Fundus photo.
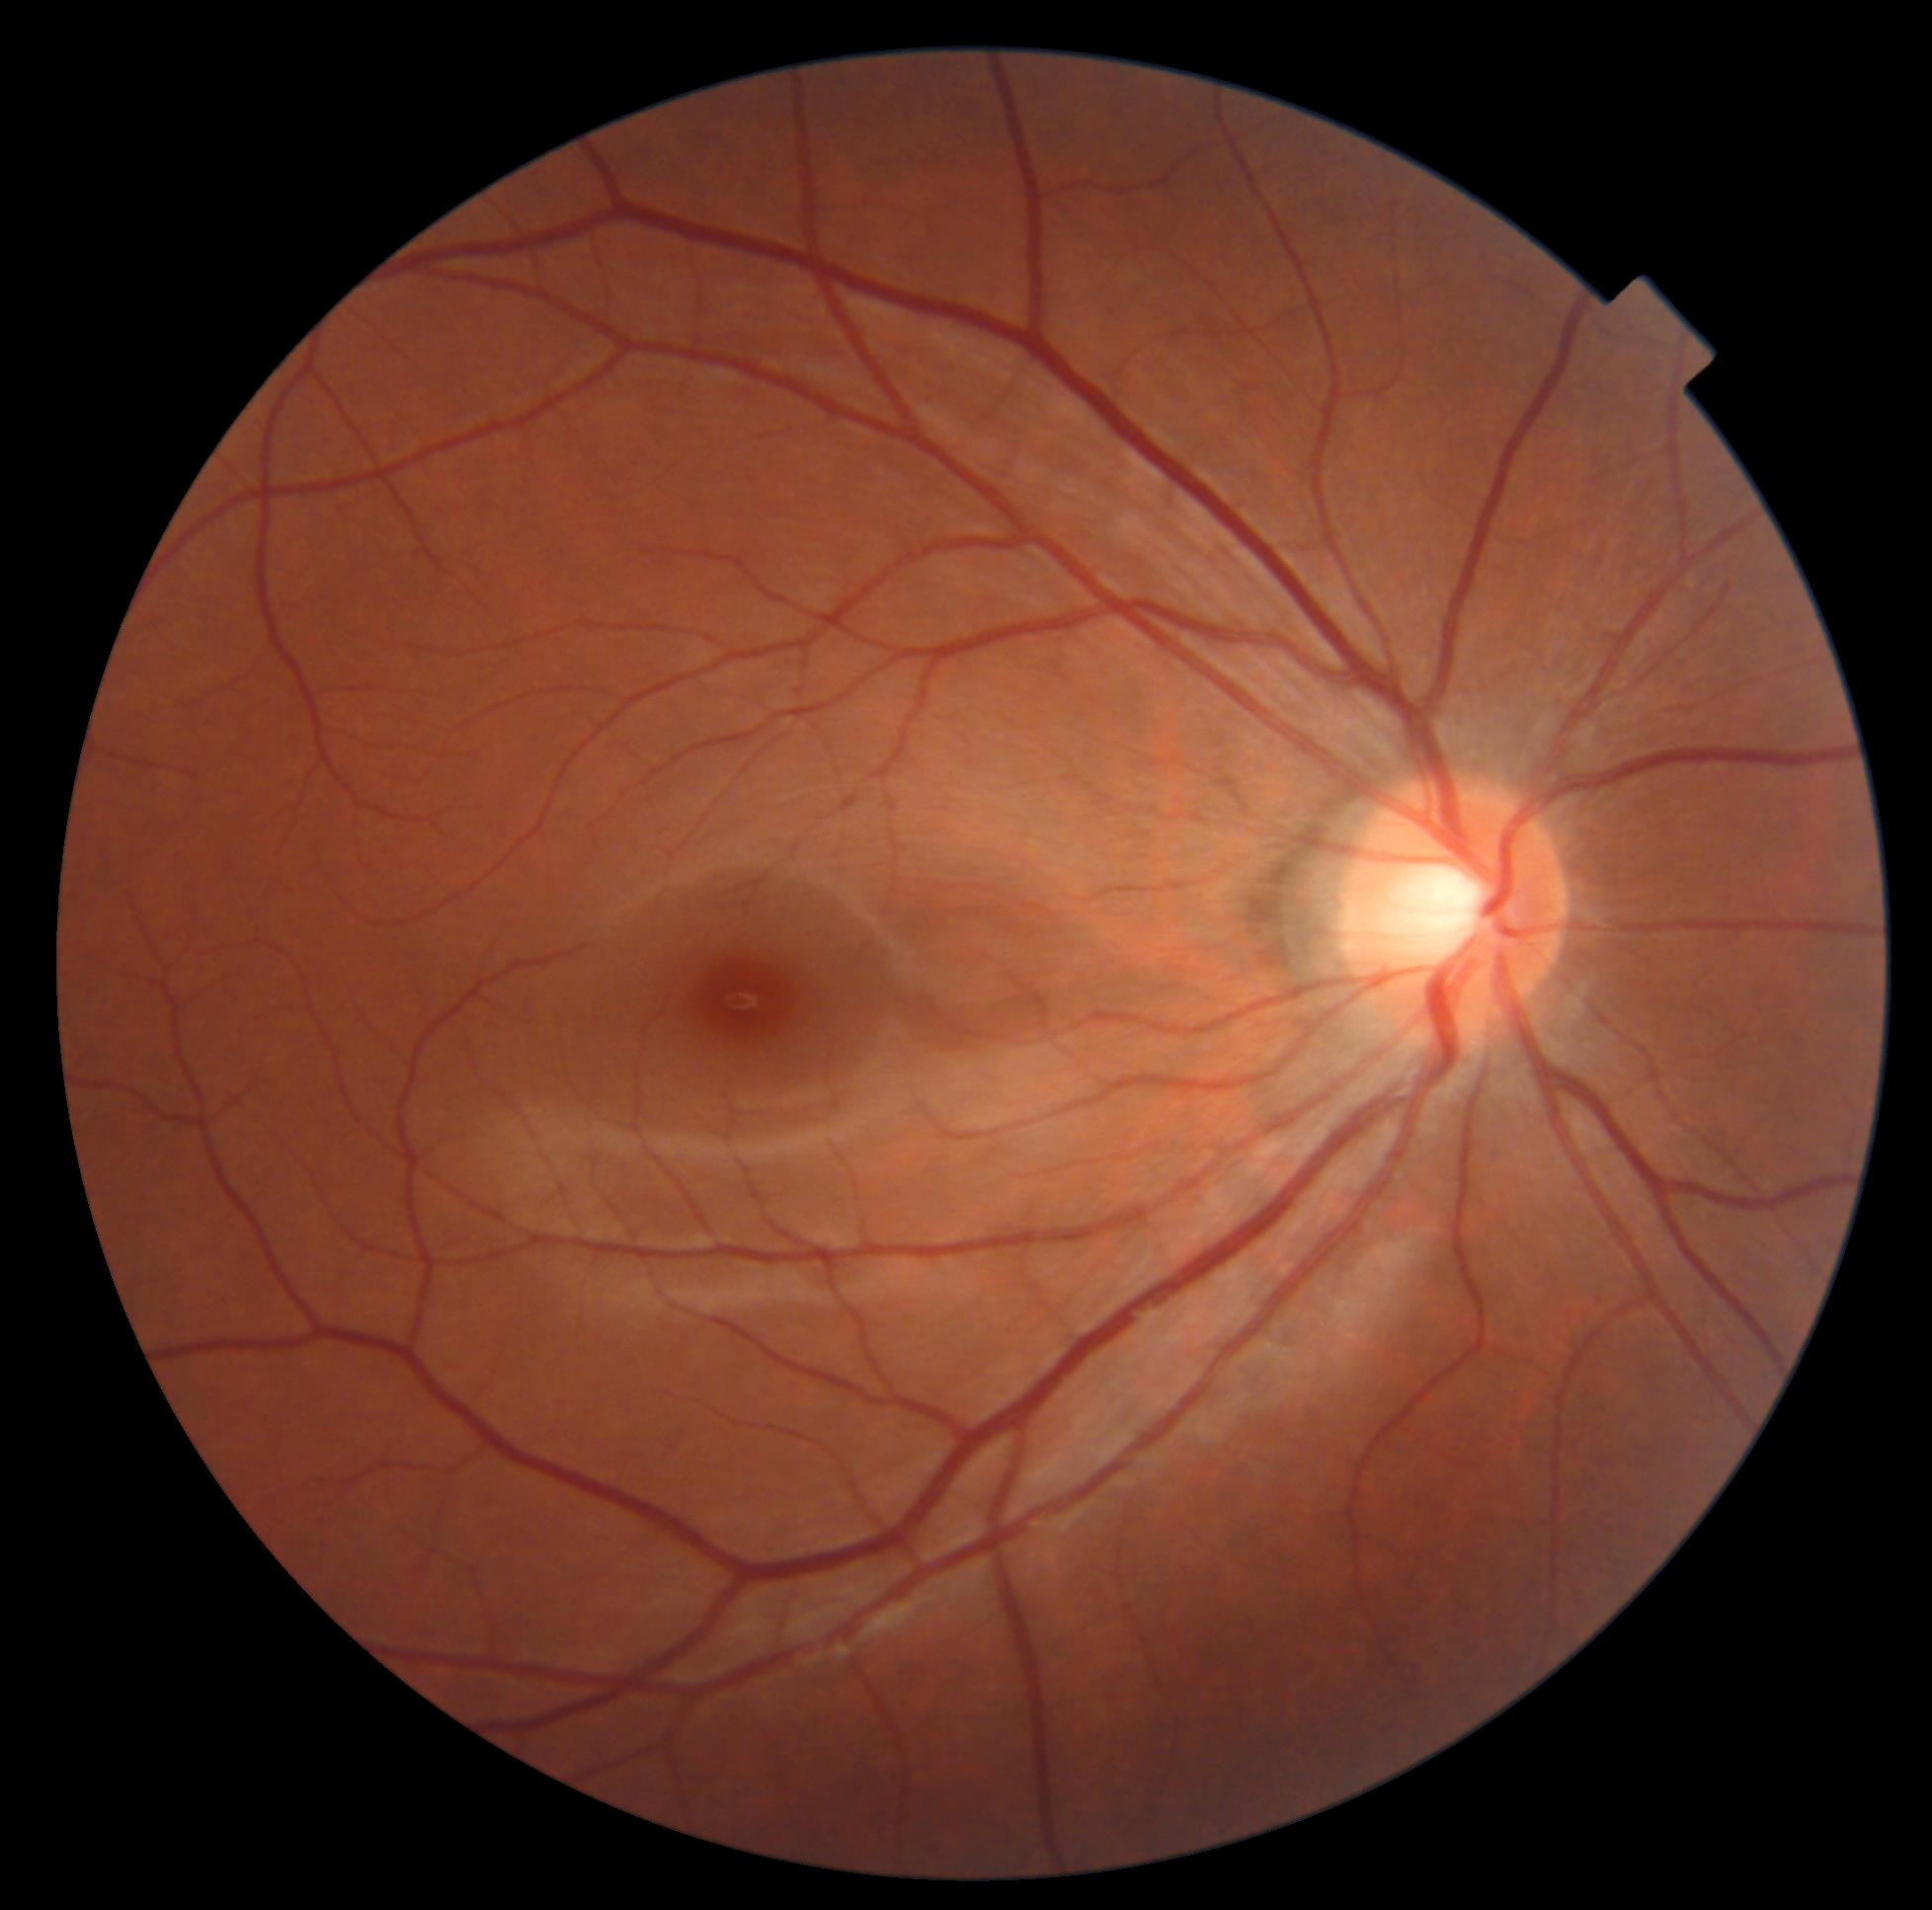 Diabetic retinopathy (DR): 0.